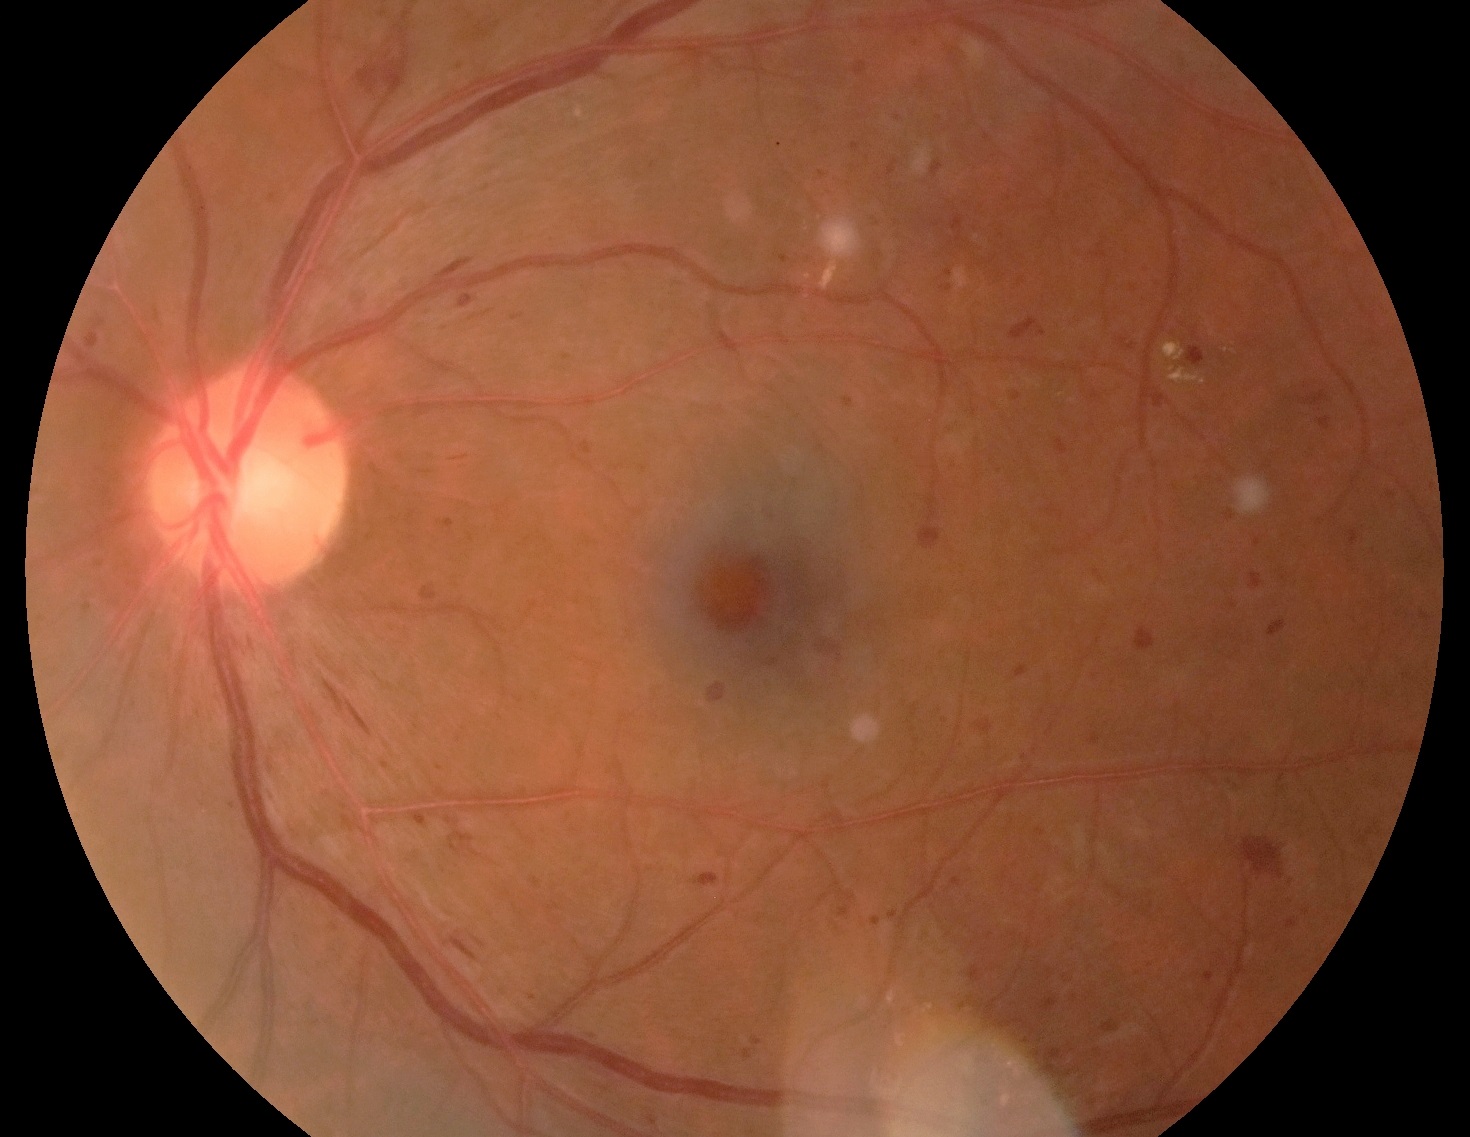 Diabetic retinopathy: grade 3.